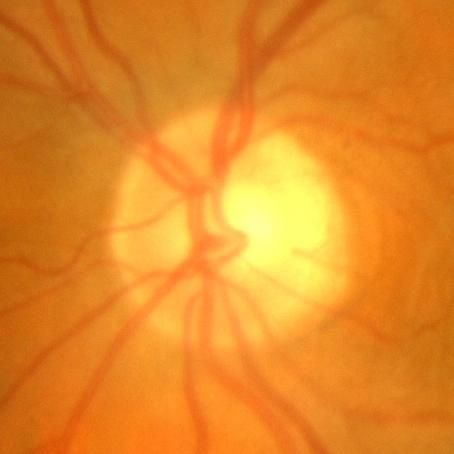 No evidence of glaucoma.